Wide-field fundus image from infant ROP screening. 640x480px: 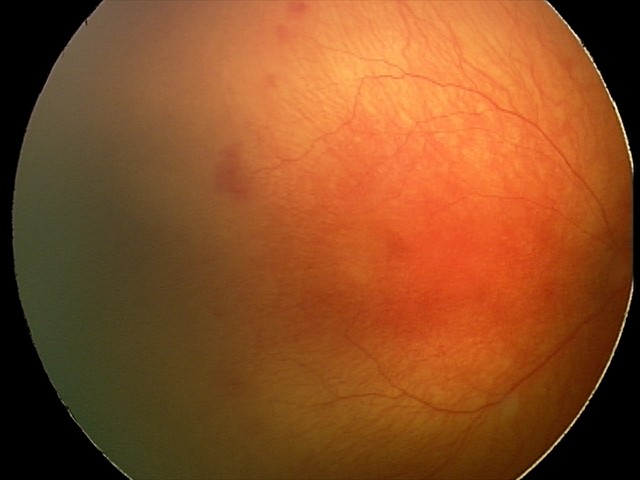

Diagnosis = aggressive retinopathy of prematurity.